IOP 16 mmHg (non-contact tonometry); axial length 23.31 mm; man; camera: Topcon TRC-NW400
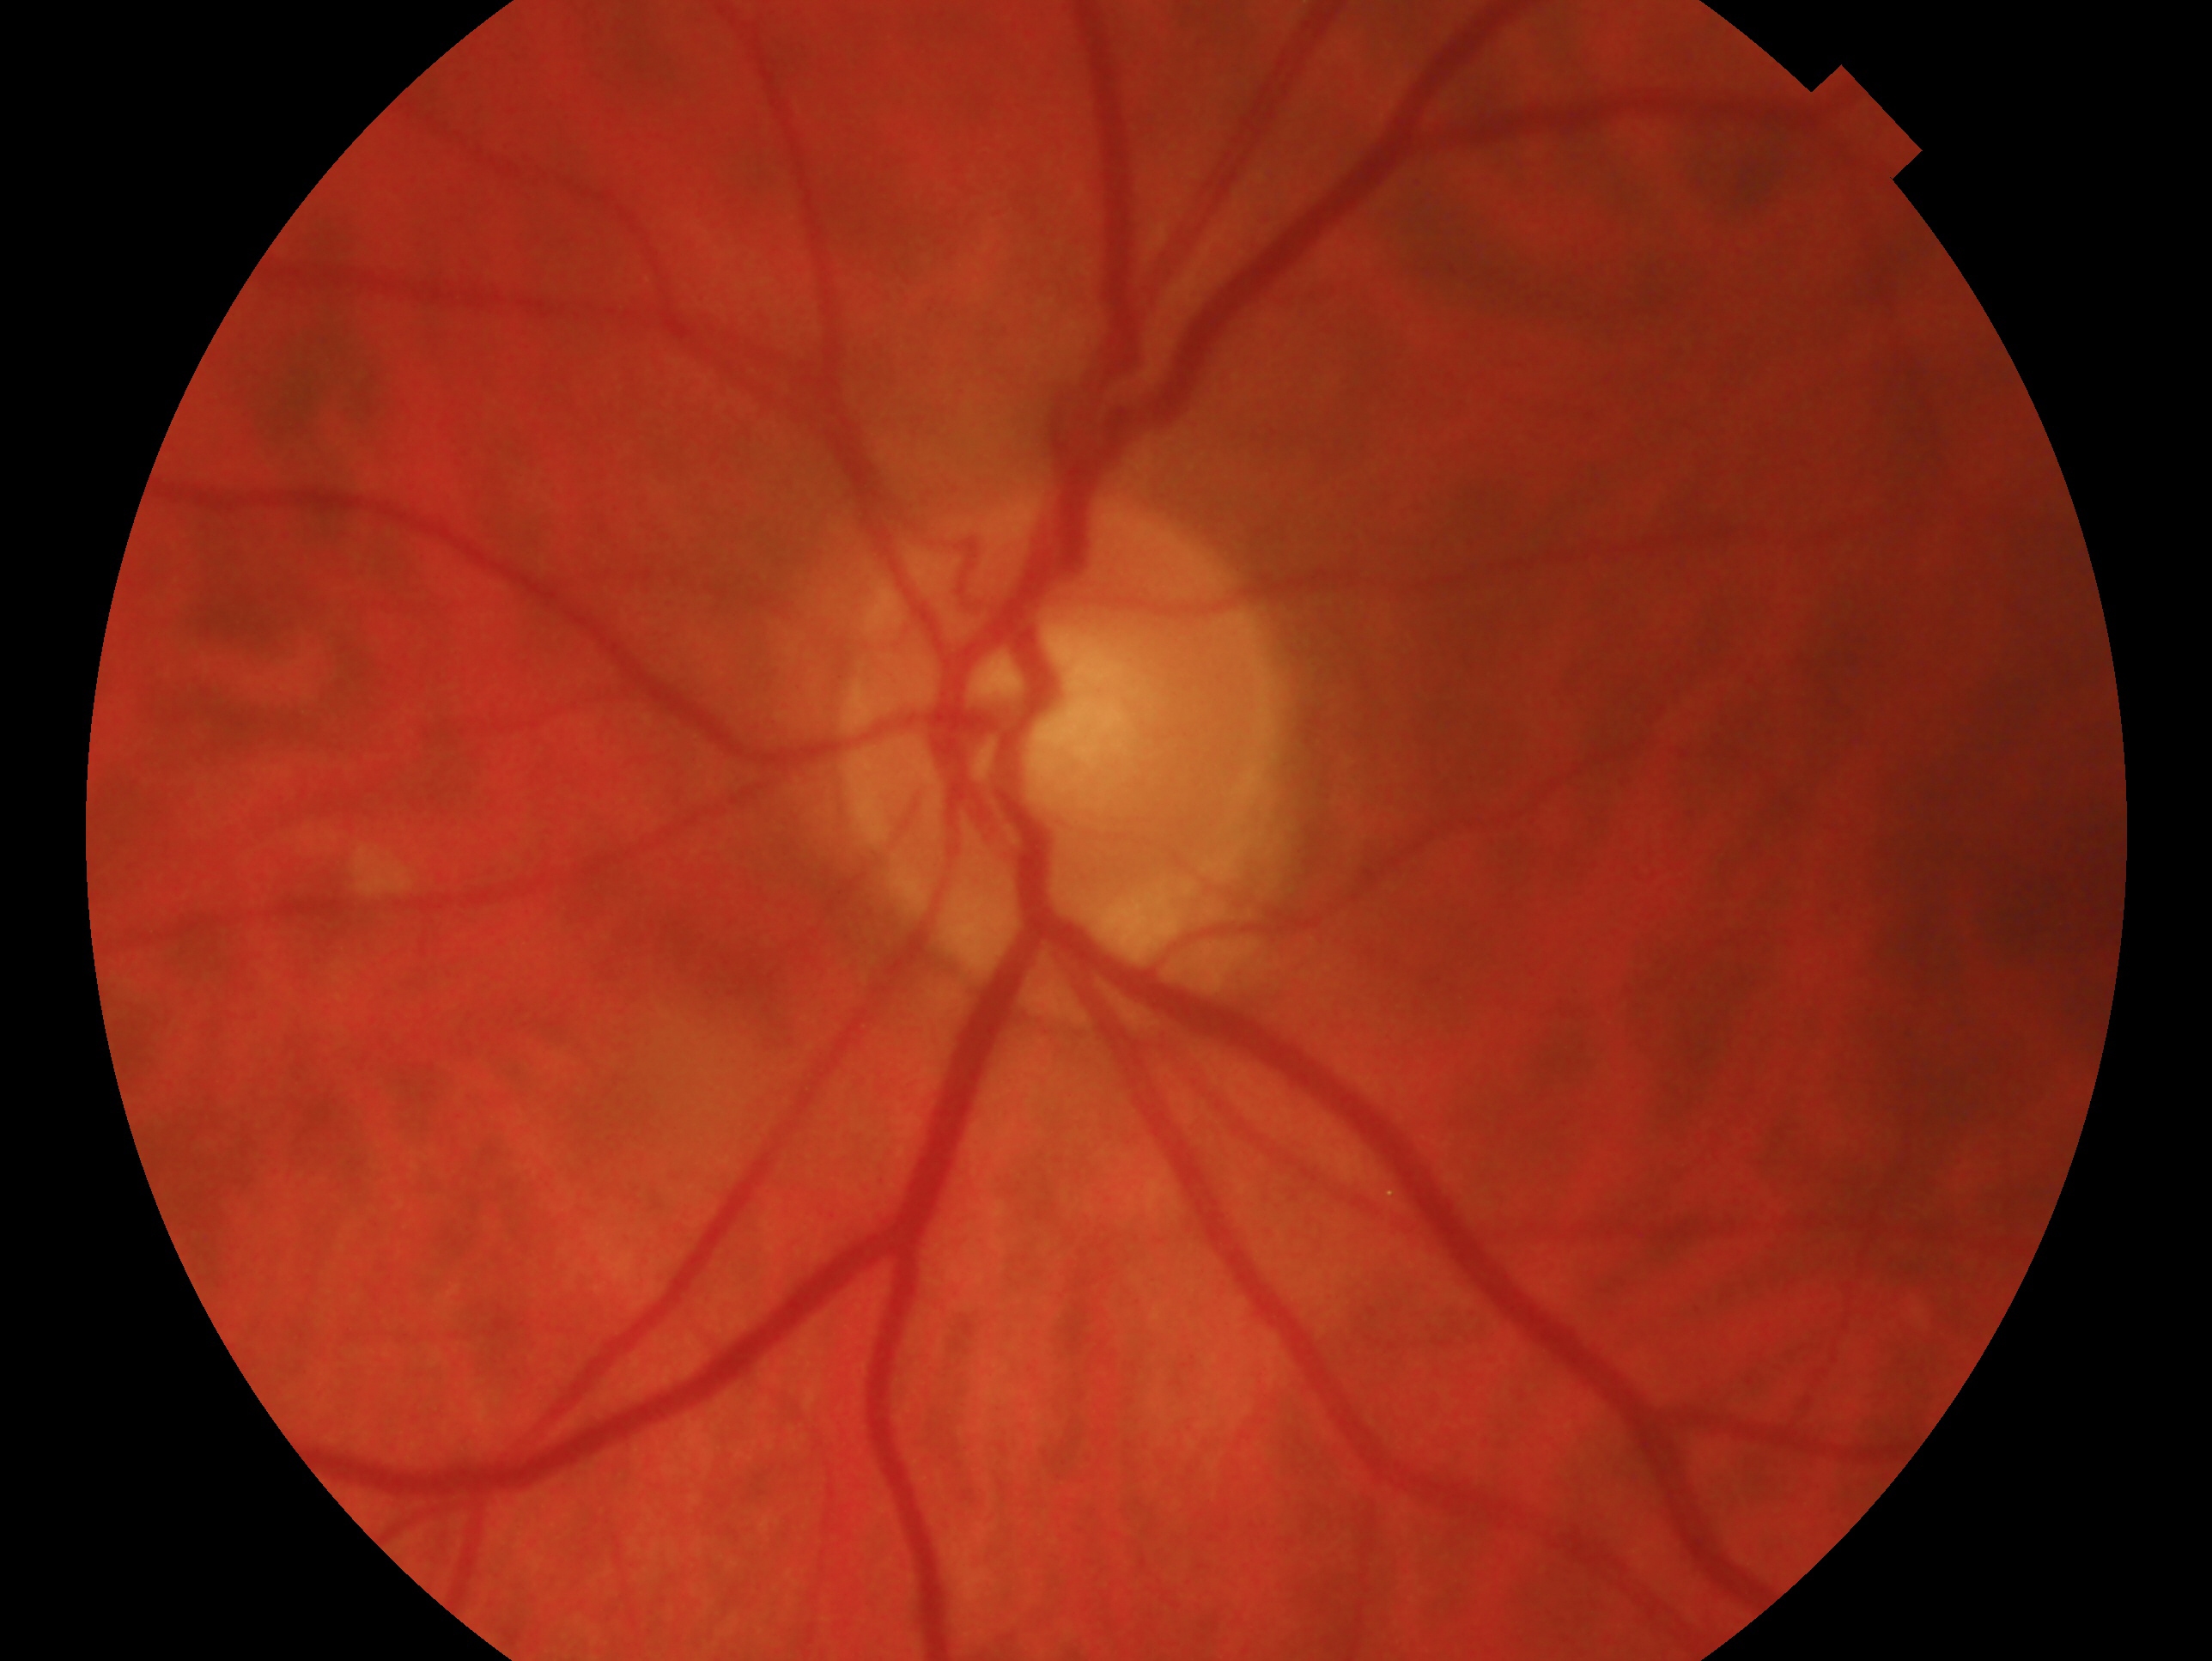 Imaged eye: OS. Glaucoma assessment — no glaucoma.